RetCam wide-field infant fundus image · 640 by 480 pixels.
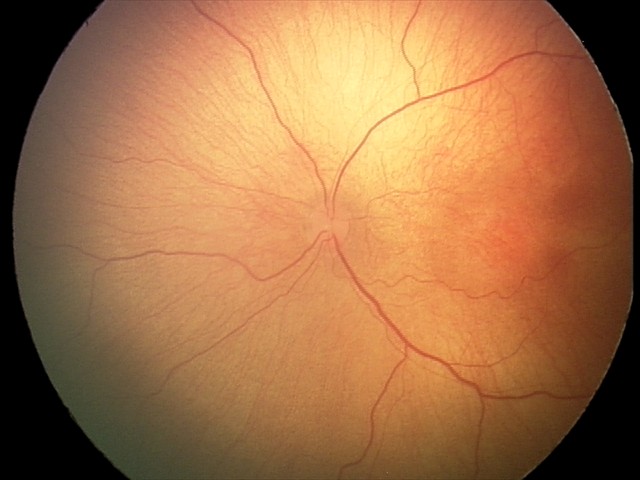
Q: Plus disease status?
A: no plus disease
Q: What was the screening finding?
A: retinopathy of prematurity (ROP) stage 2